Image size 2212x1672
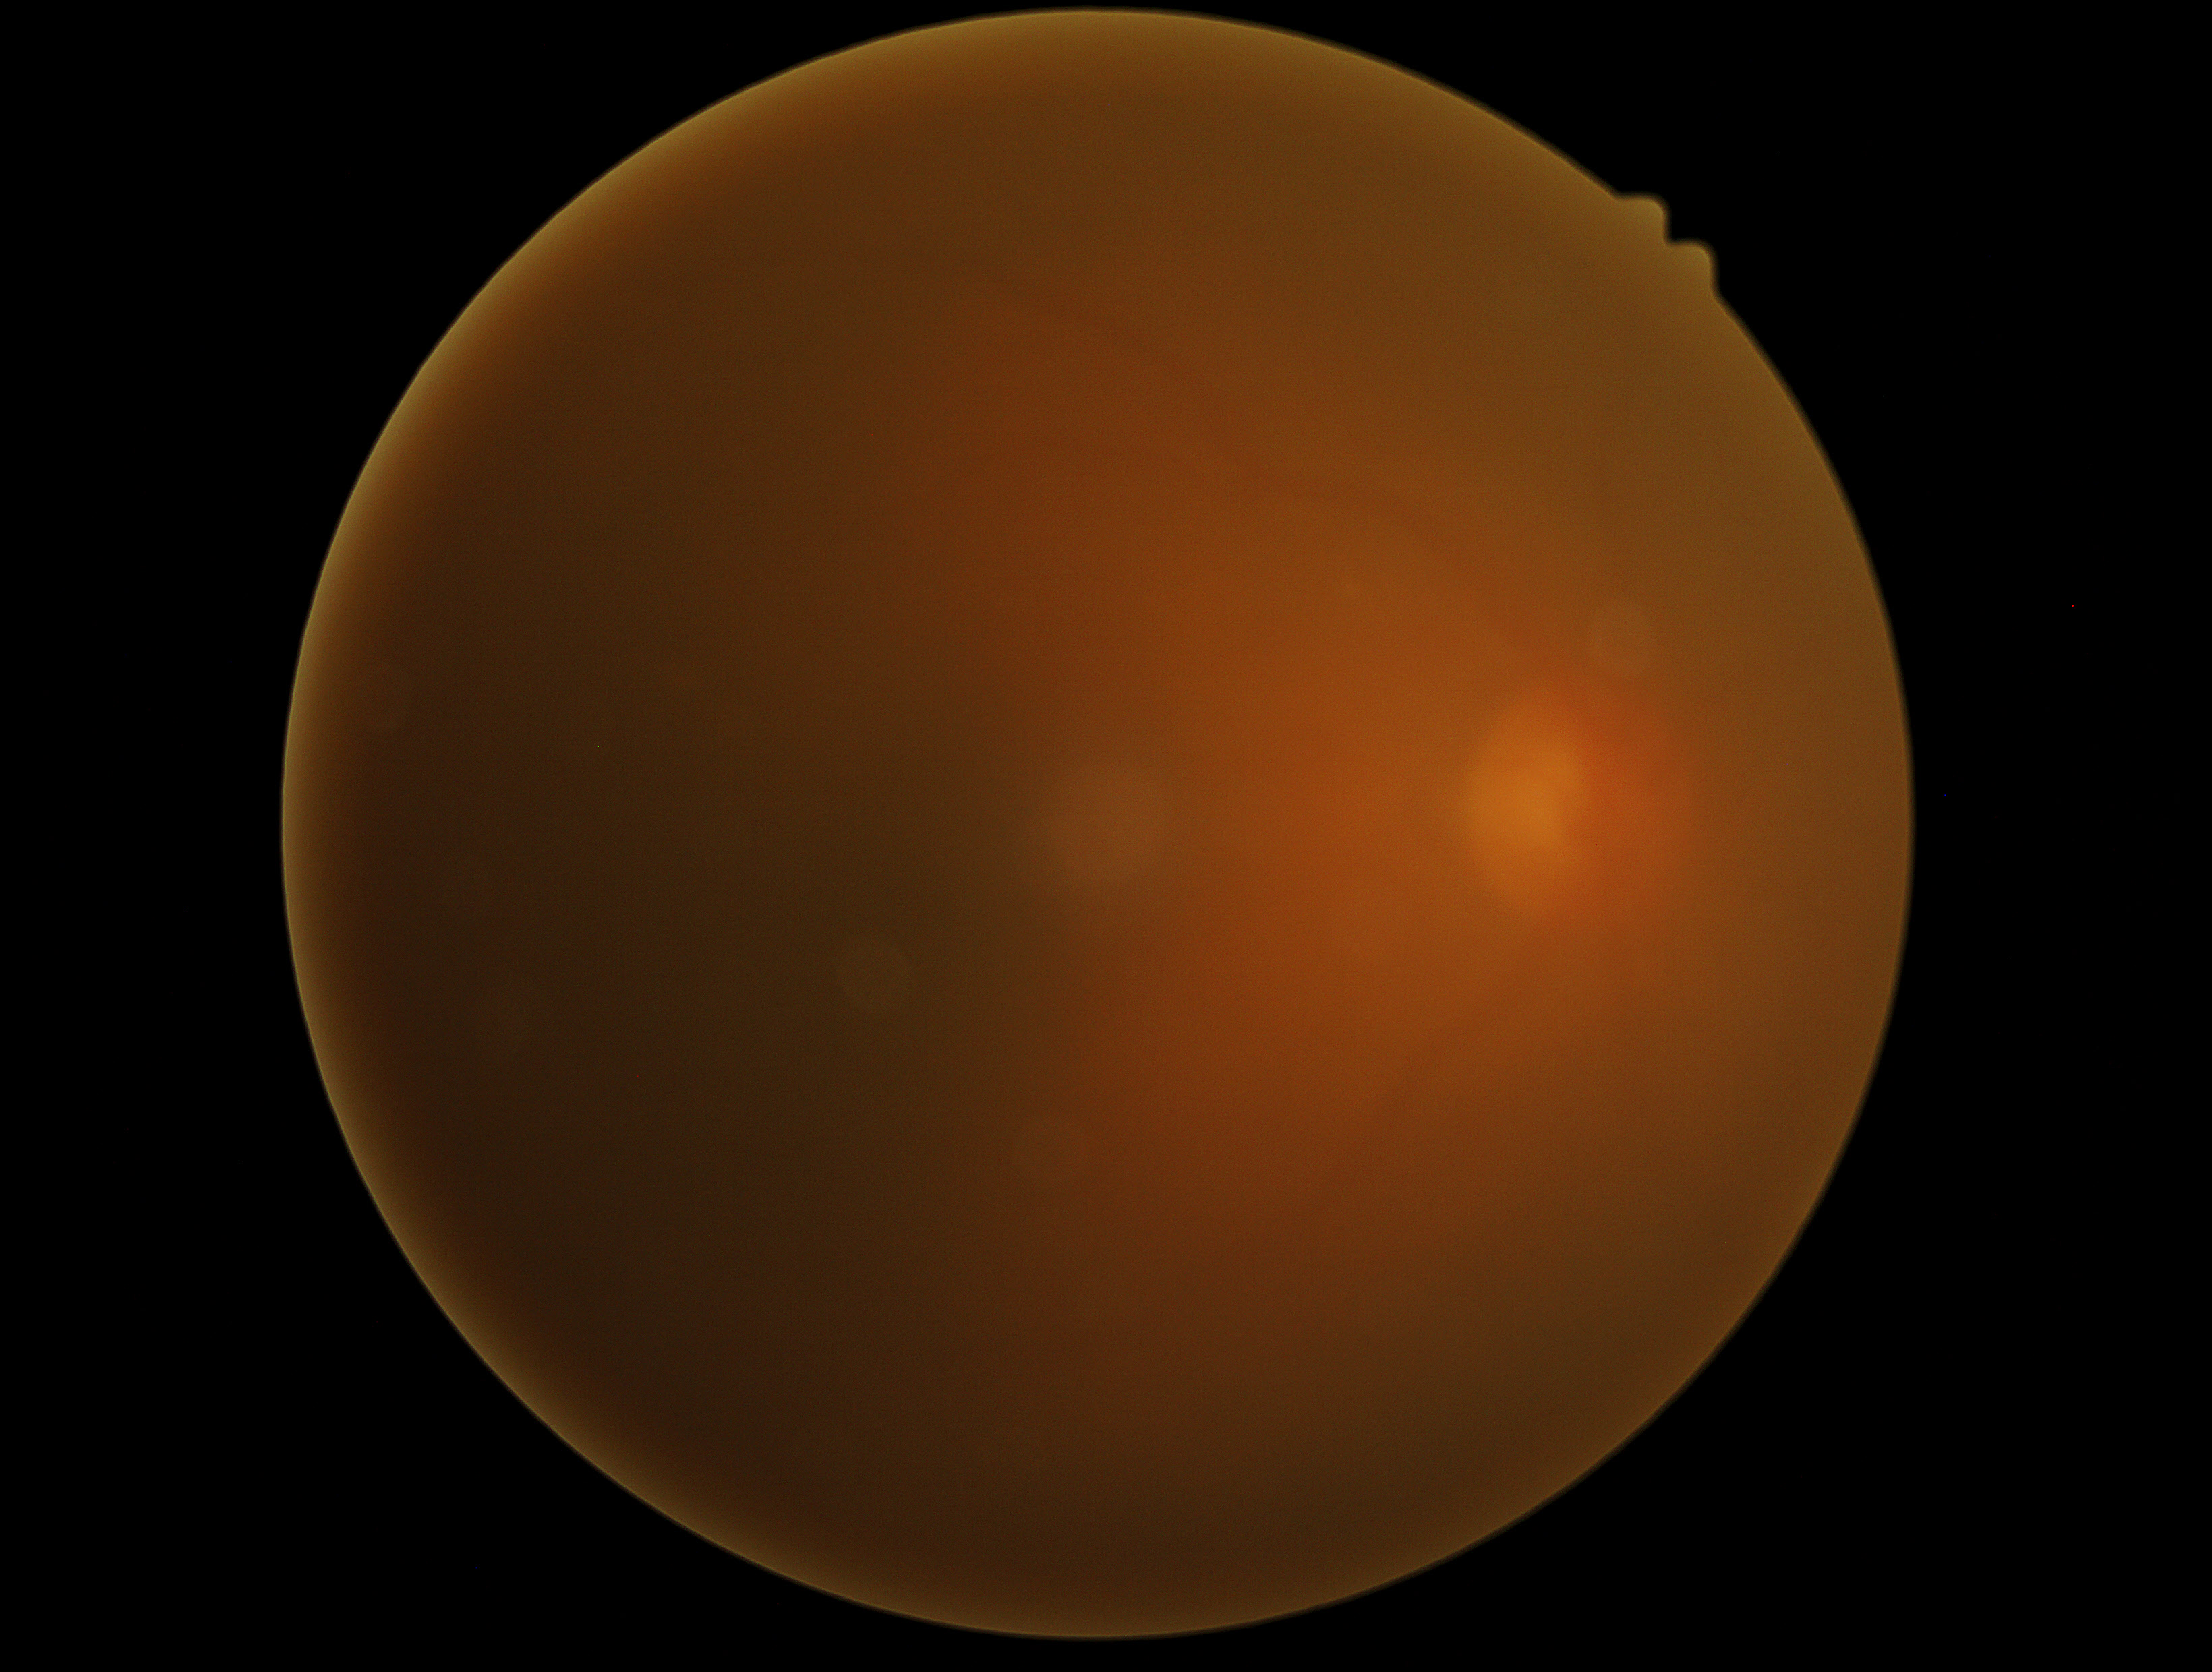

DR stage: ungradable.